Camera: Nidek AFC-330: 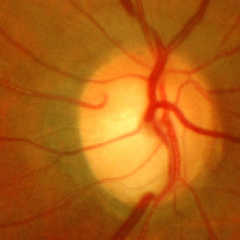

Glaucoma is present. Showing early glaucoma.